Camera: NIDEK AFC-230, diabetic retinopathy graded by the modified Davis classification: 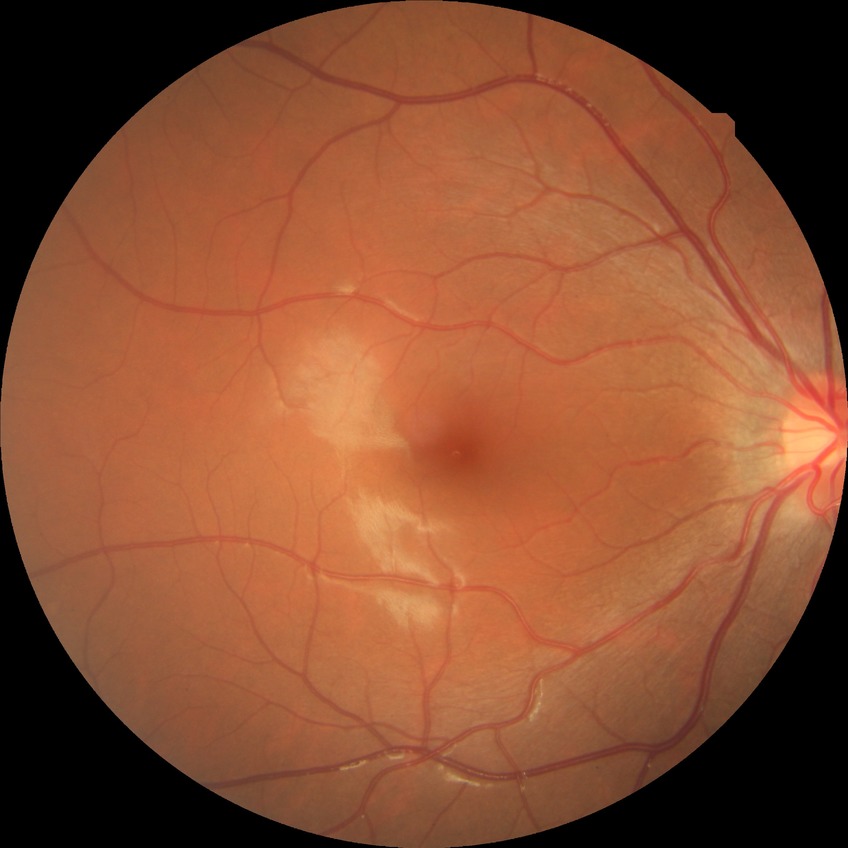 Modified Davis grade: SDR.